FOV: 45 degrees; 2352x1568 — 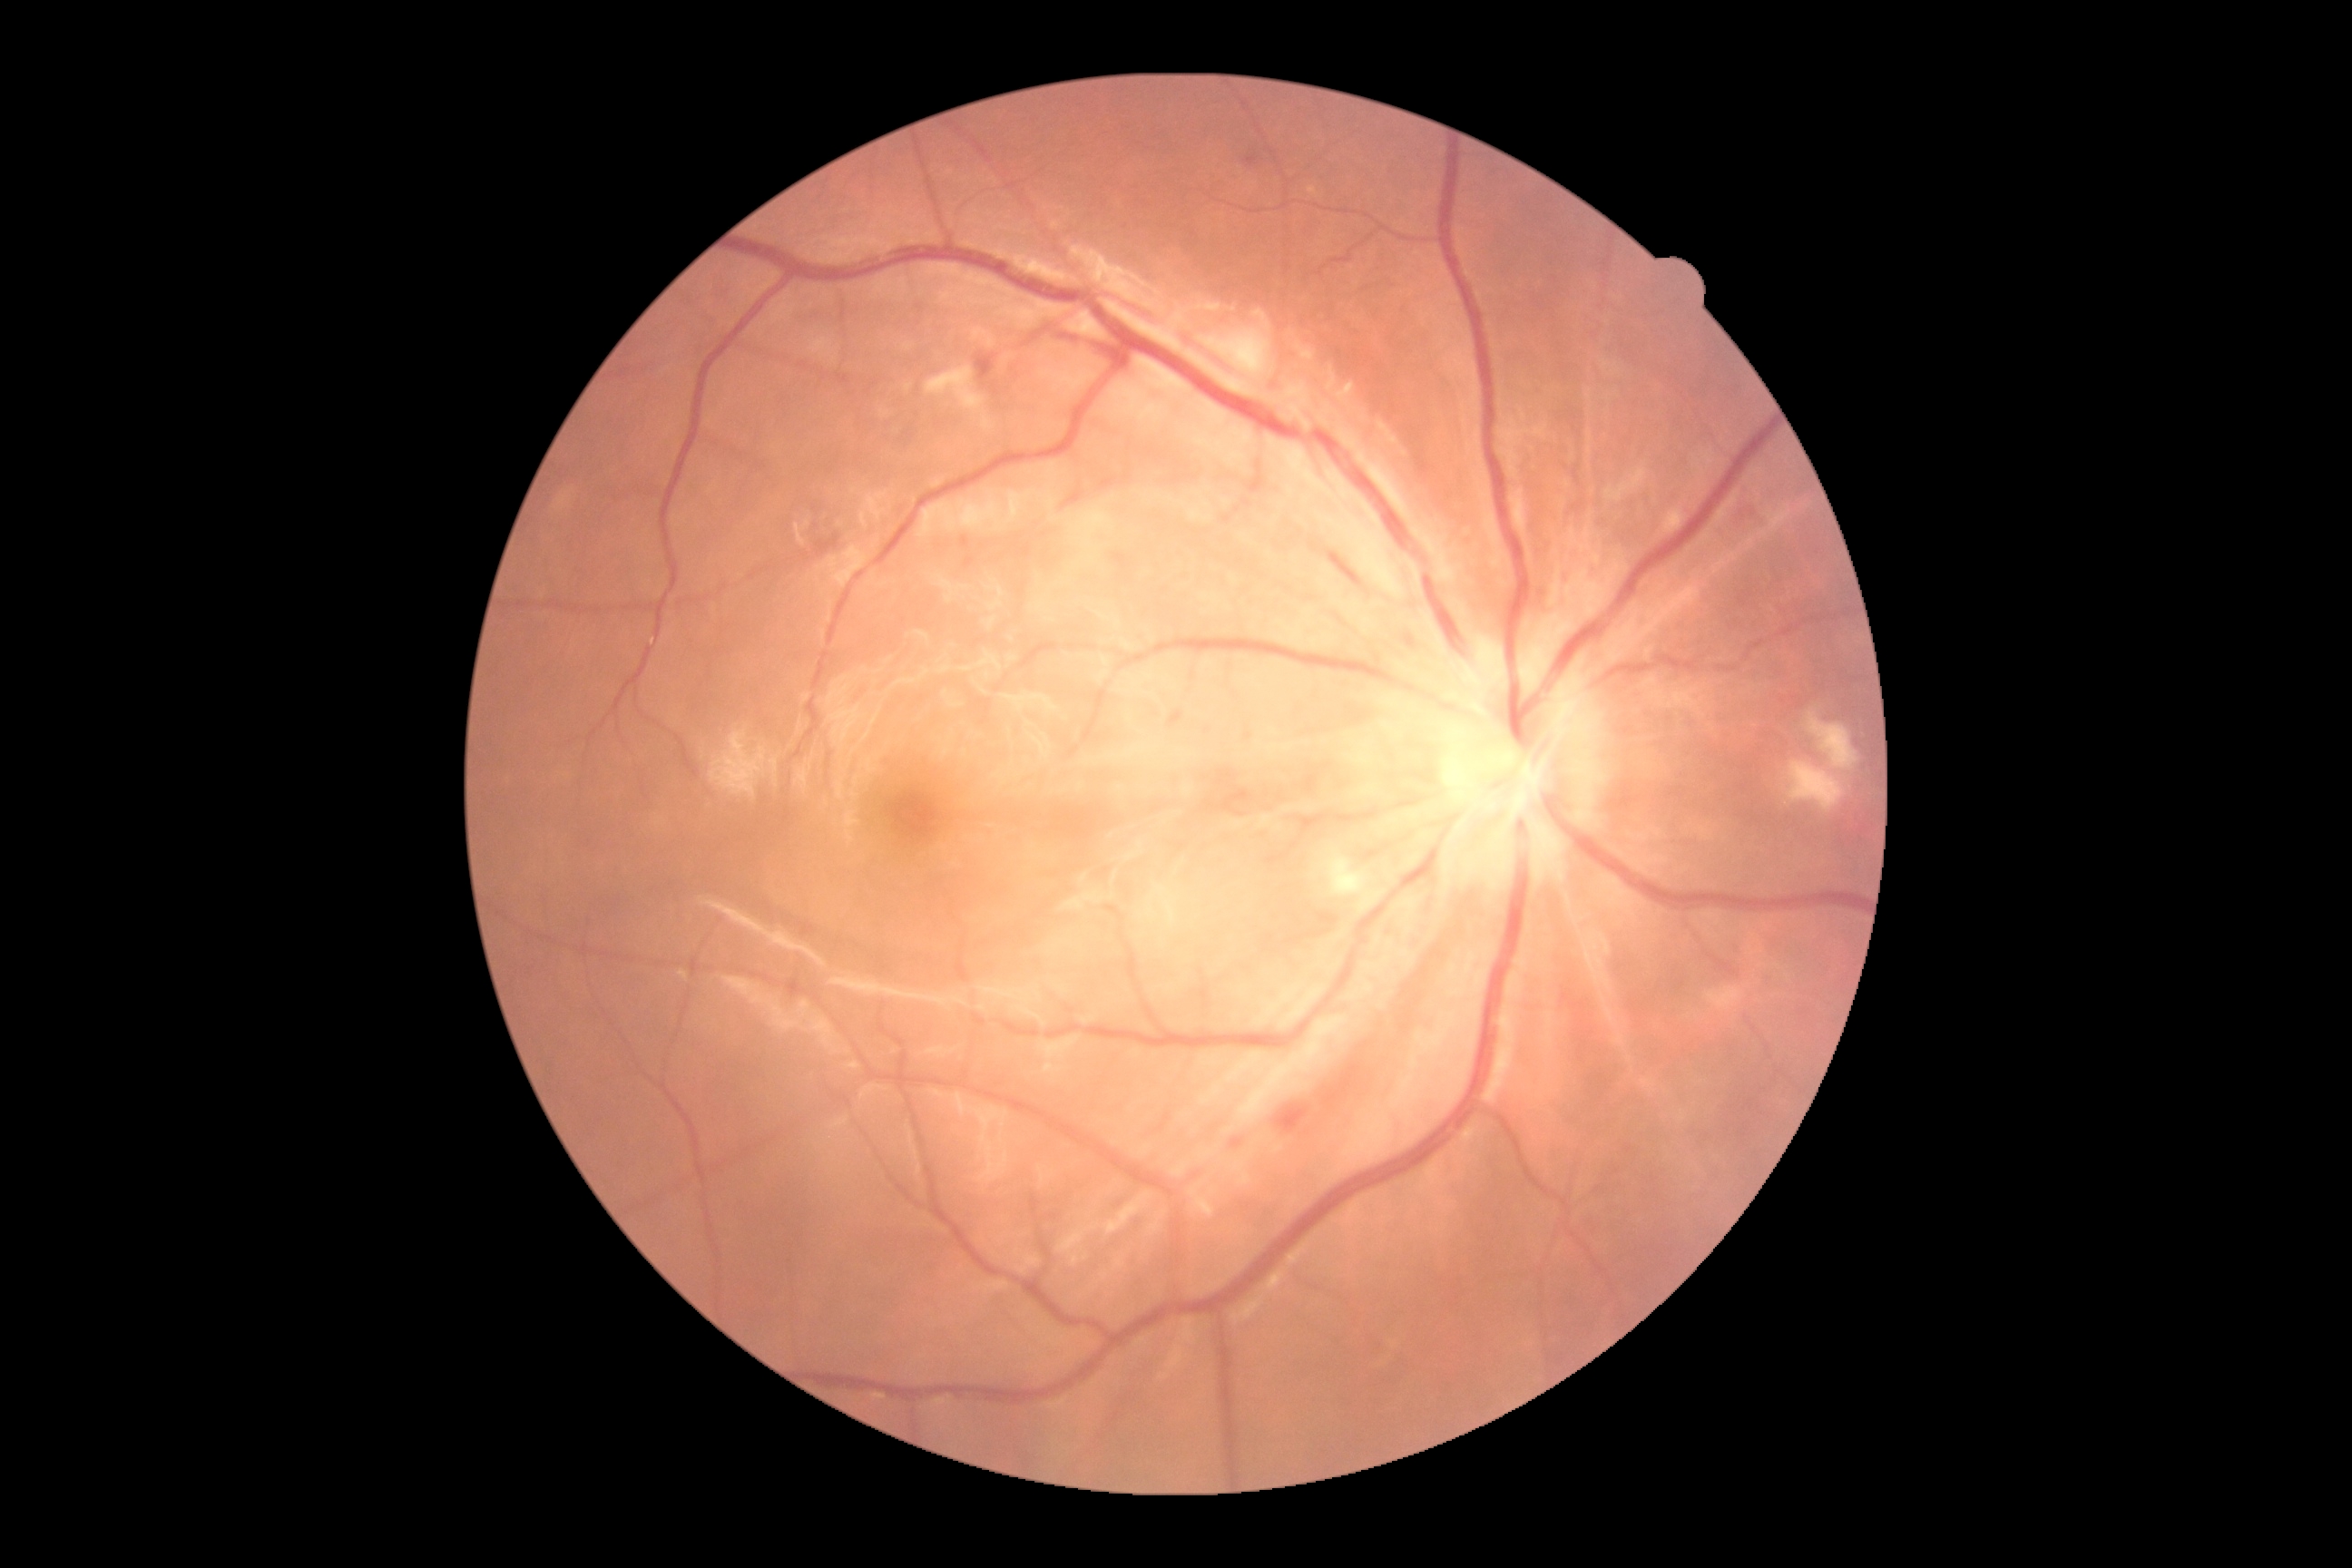 • DR class: non-proliferative diabetic retinopathy
• diabetic retinopathy (DR): 2 — more than just microaneurysms but less than severe NPDR